Image size 1240x1240. Acquired on the Phoenix ICON. Pediatric wide-field fundus photograph — 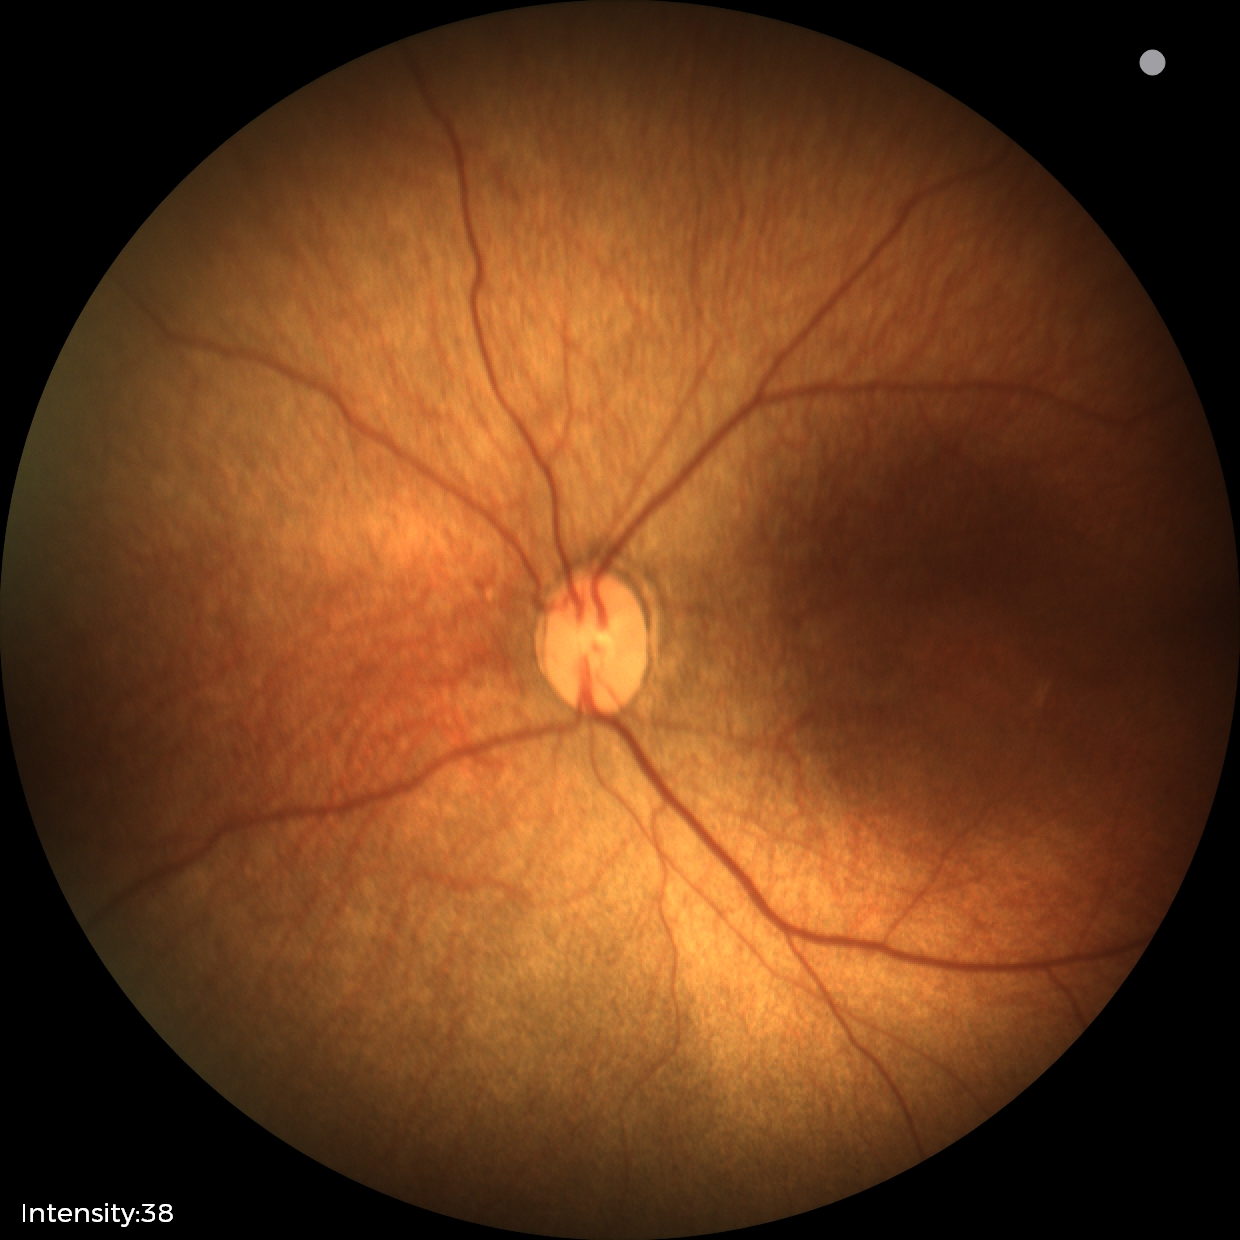

Without plus disease.
Series diagnosed as status post retinopathy of prematurity (ROP).